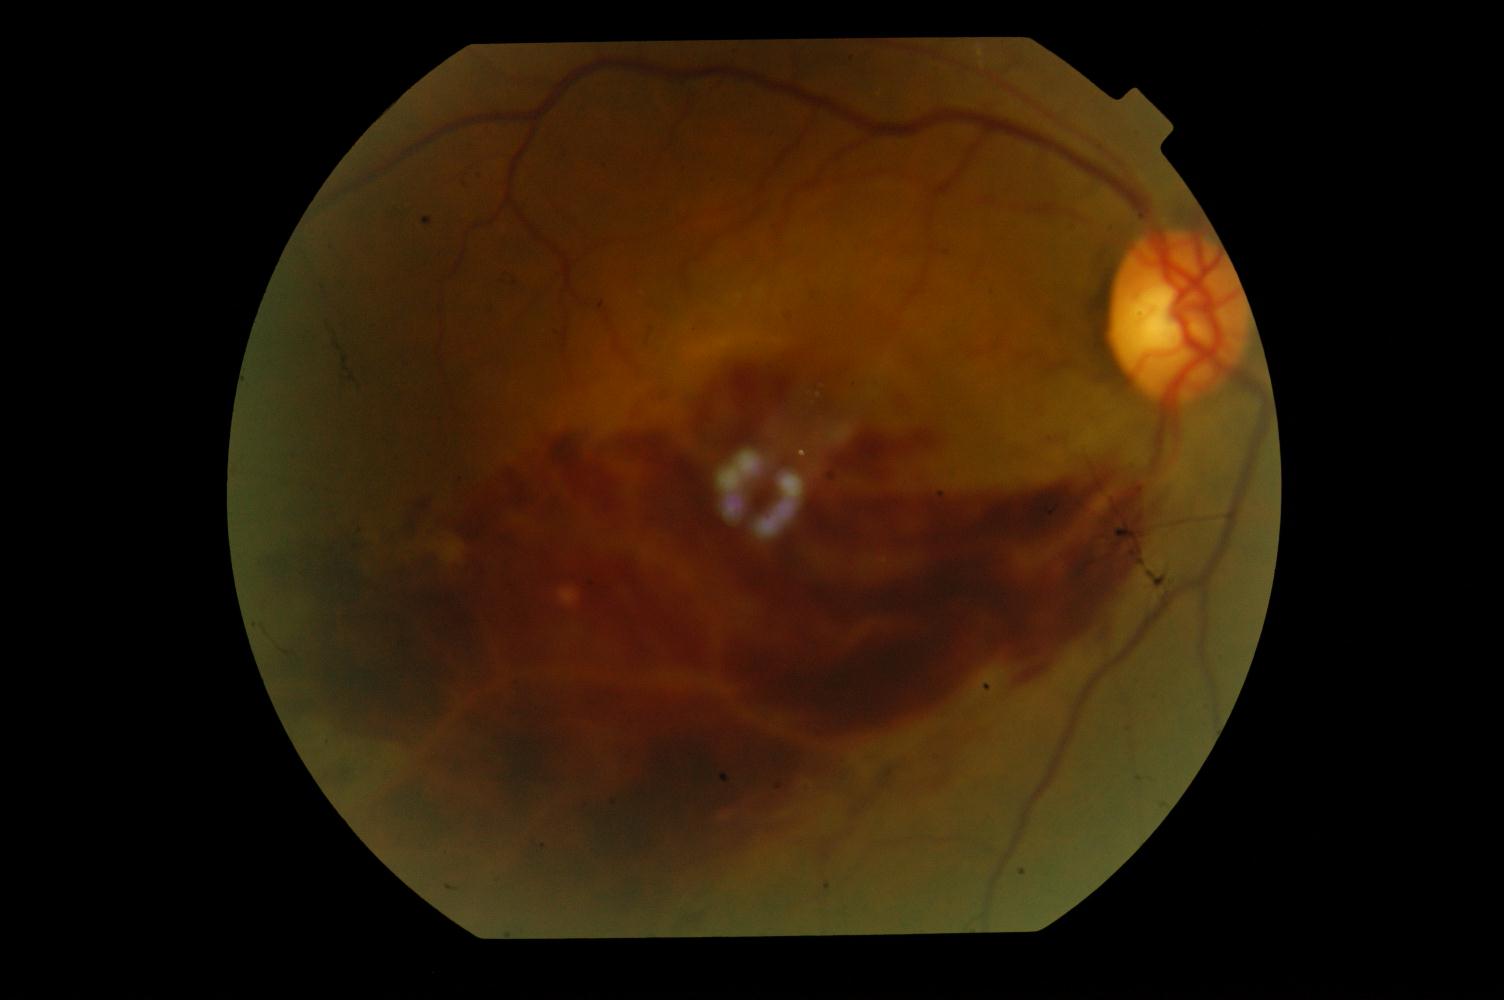

Demonstrates branch retinal vein occlusion.